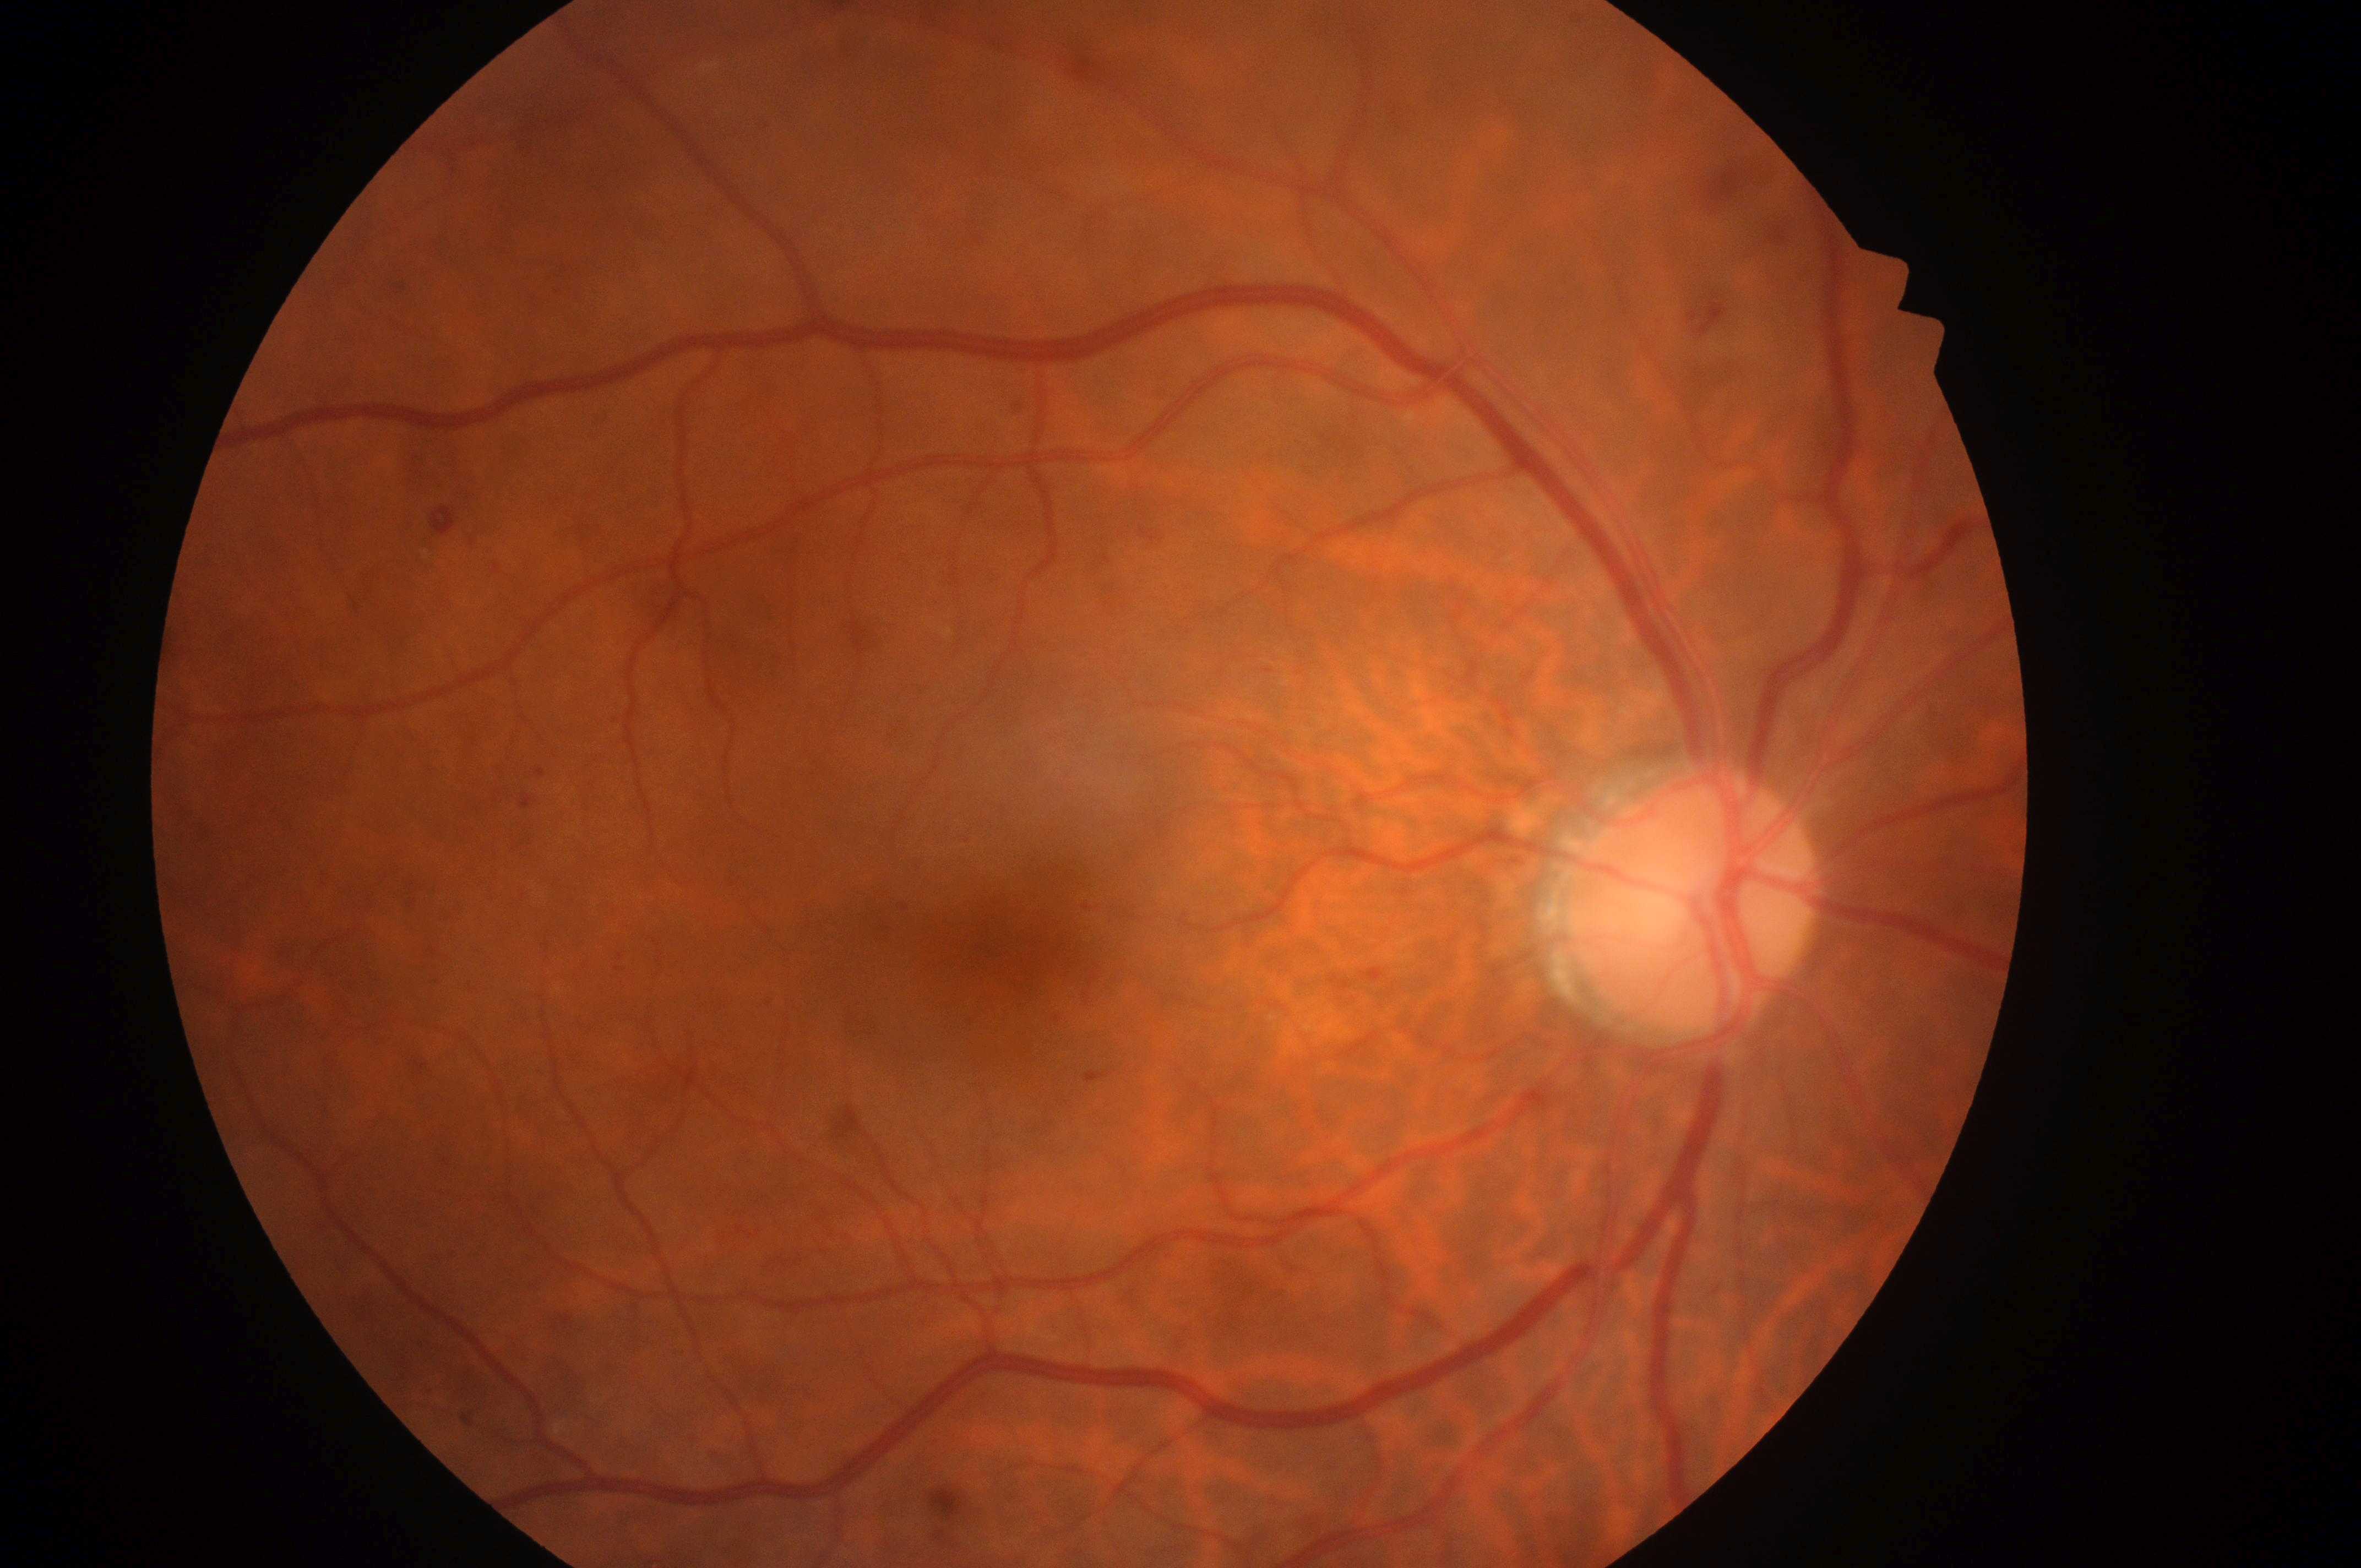

Optic disc located at 1689, 911. This is the right eye. Diabetic retinopathy (DR) is moderate non-proliferative diabetic retinopathy (grade 2). Fovea center located at 1004, 946. Diabetic macular edema (DME): grade 1 (low risk).